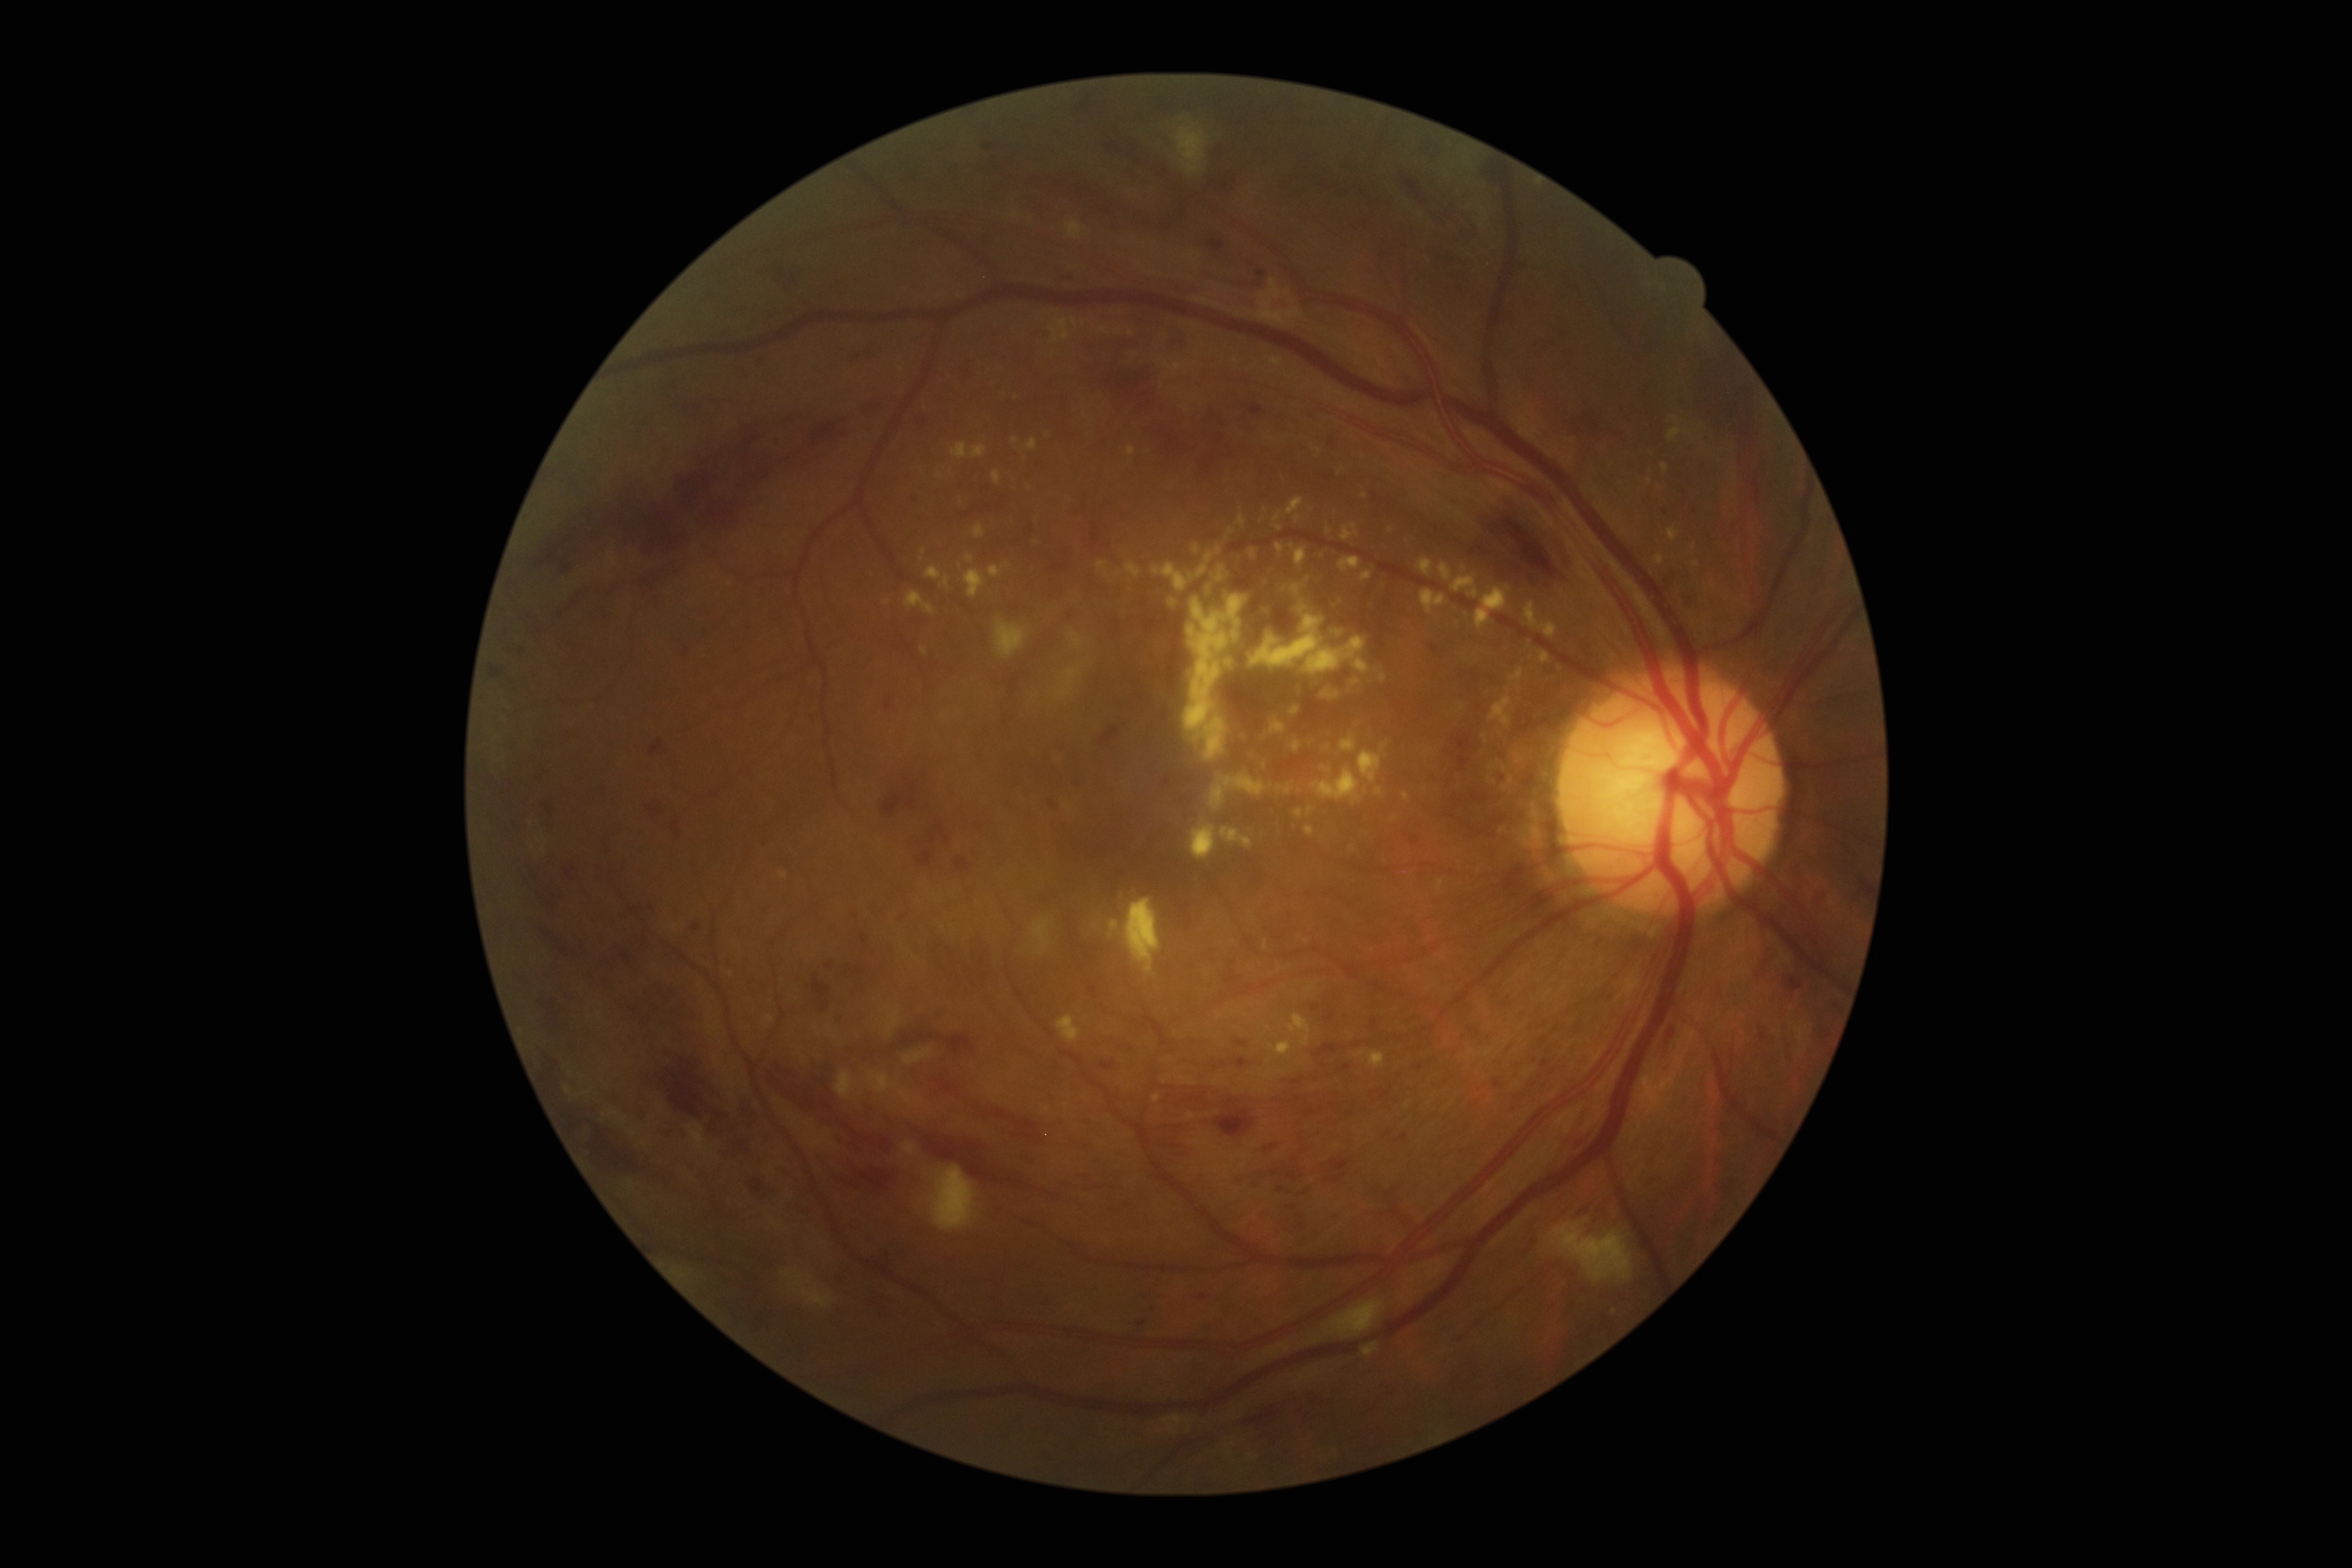

DR grade: 3.